Color fundus image, 2346x1568px — 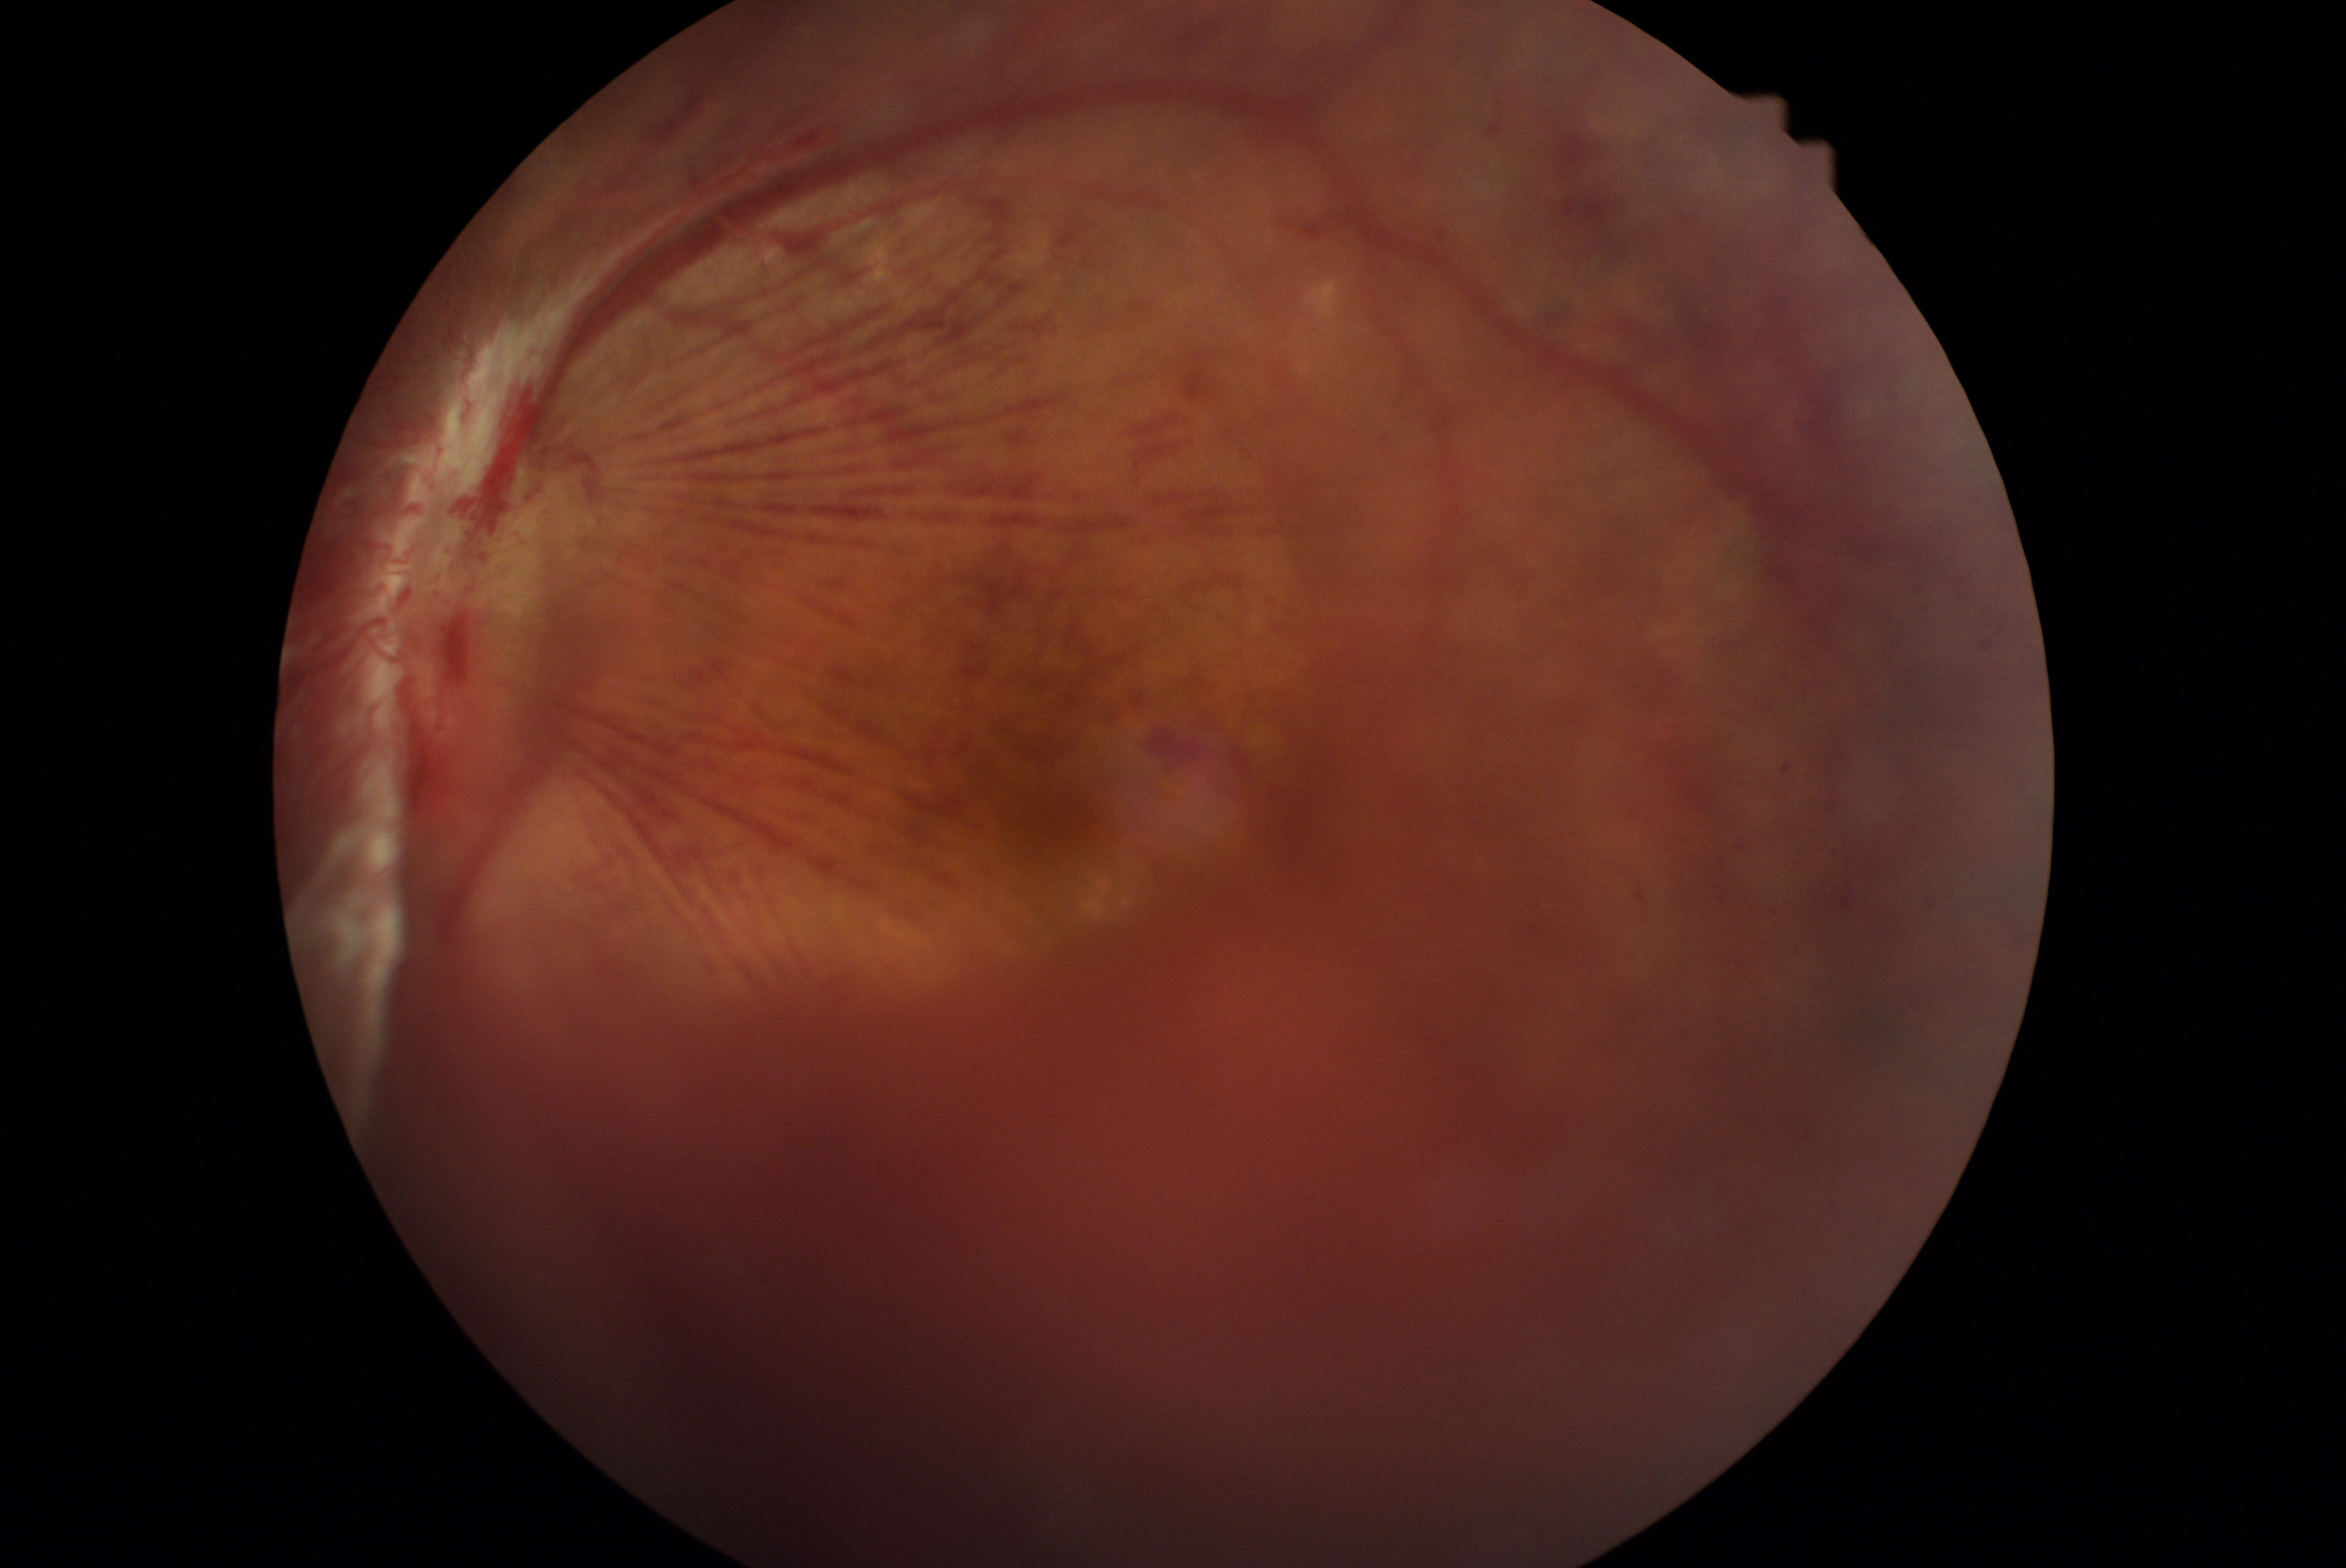

The retinopathy is classified as proliferative diabetic retinopathy.
Diabetic retinopathy is 4.